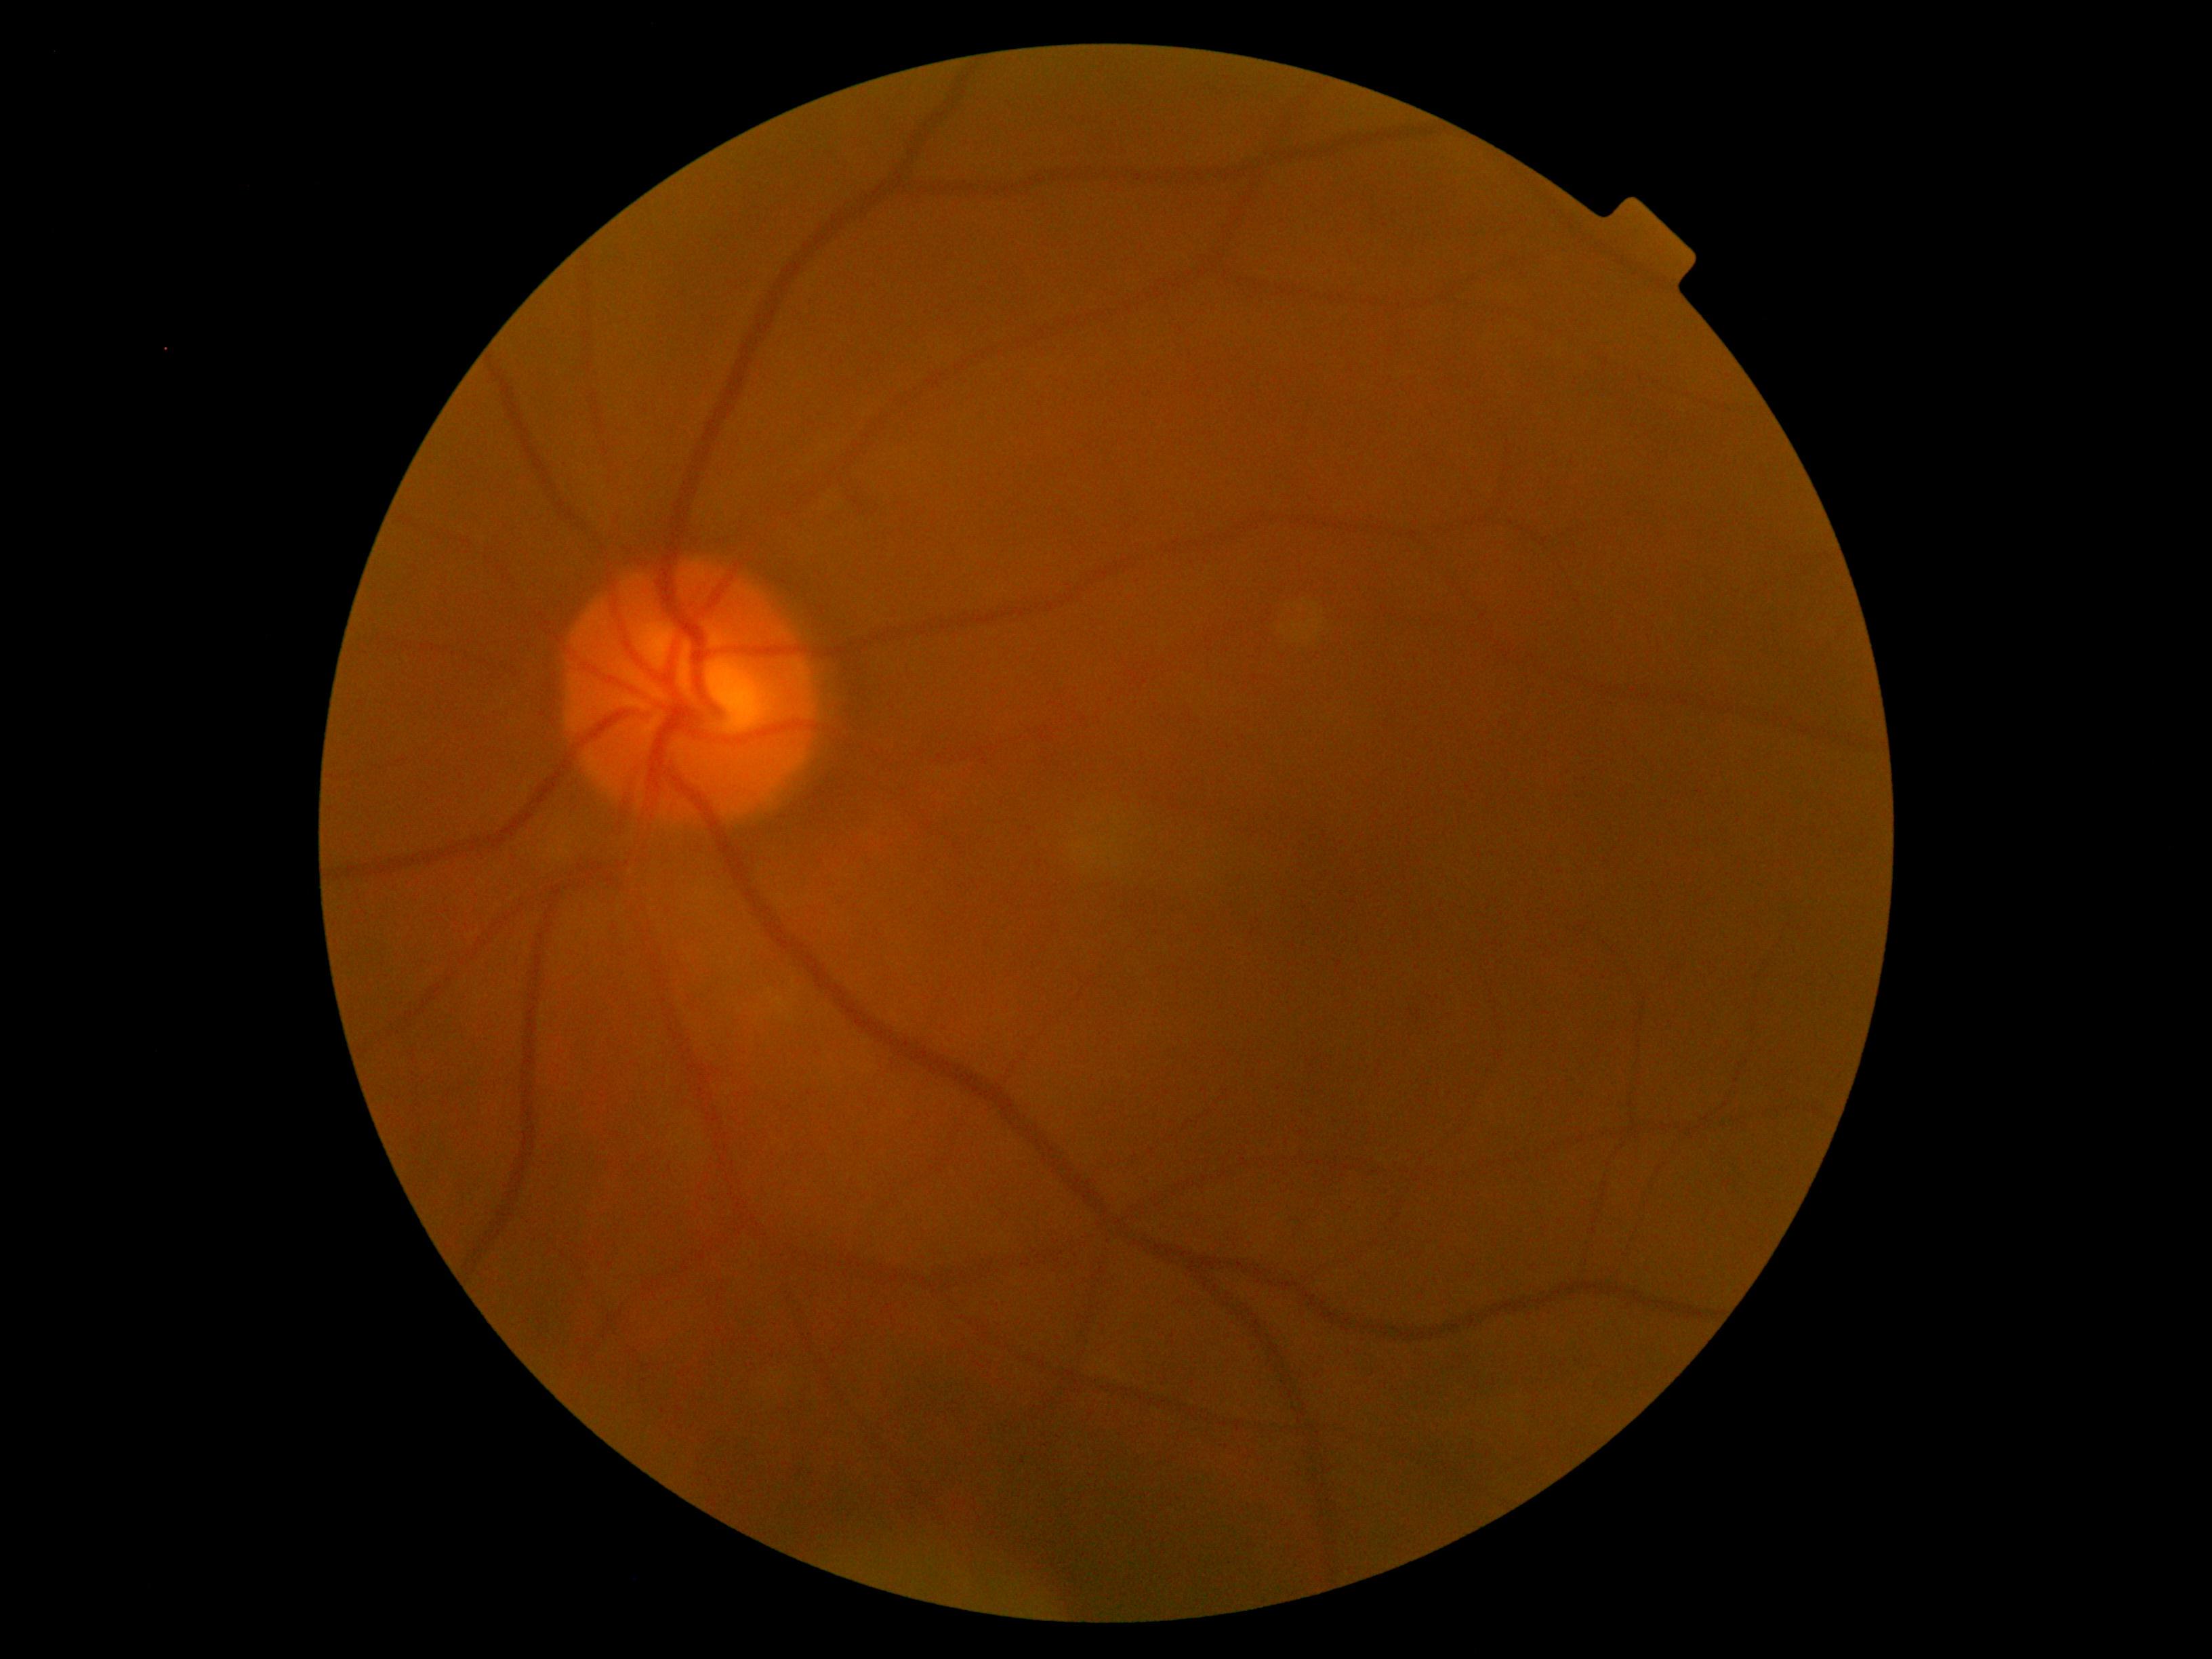
No apparent diabetic retinopathy.
Diabetic retinopathy is grade 0 (no apparent retinopathy).